1932 by 1916 pixels — 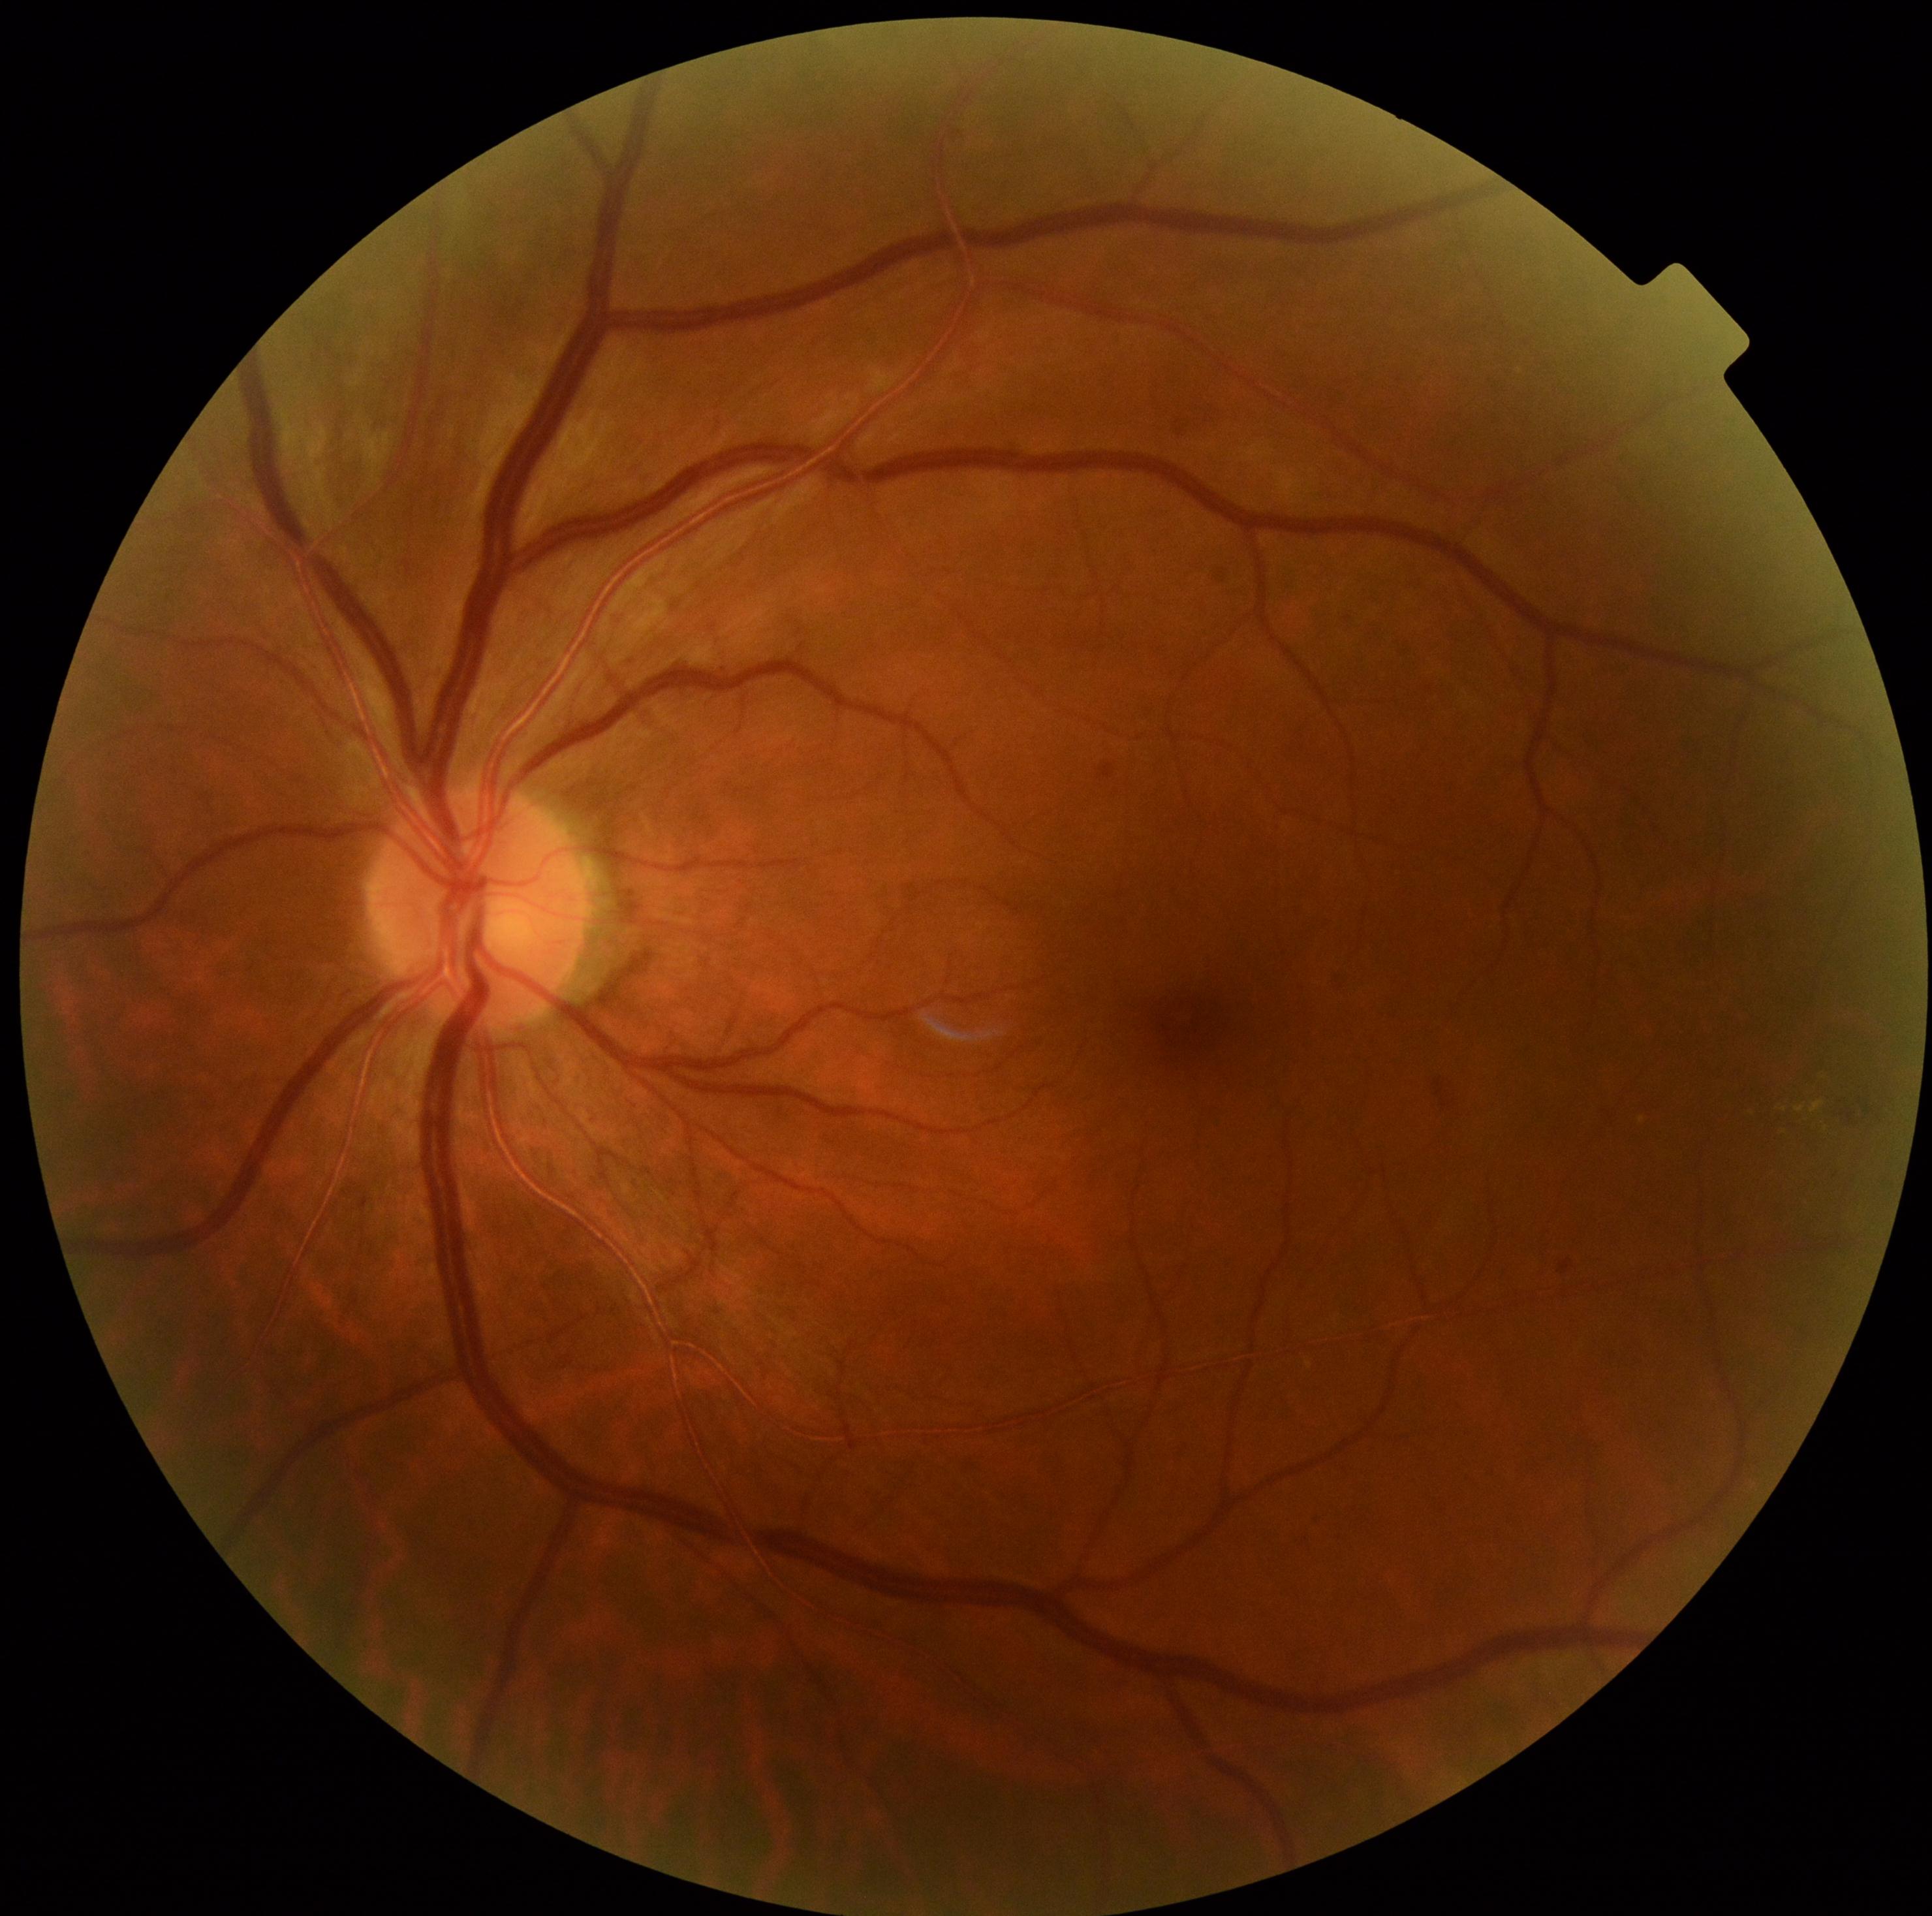

DR stage is grade 2 (moderate NPDR).